1924 by 1556 pixels. Ultra-widefield fundus mosaic. 200° FOV
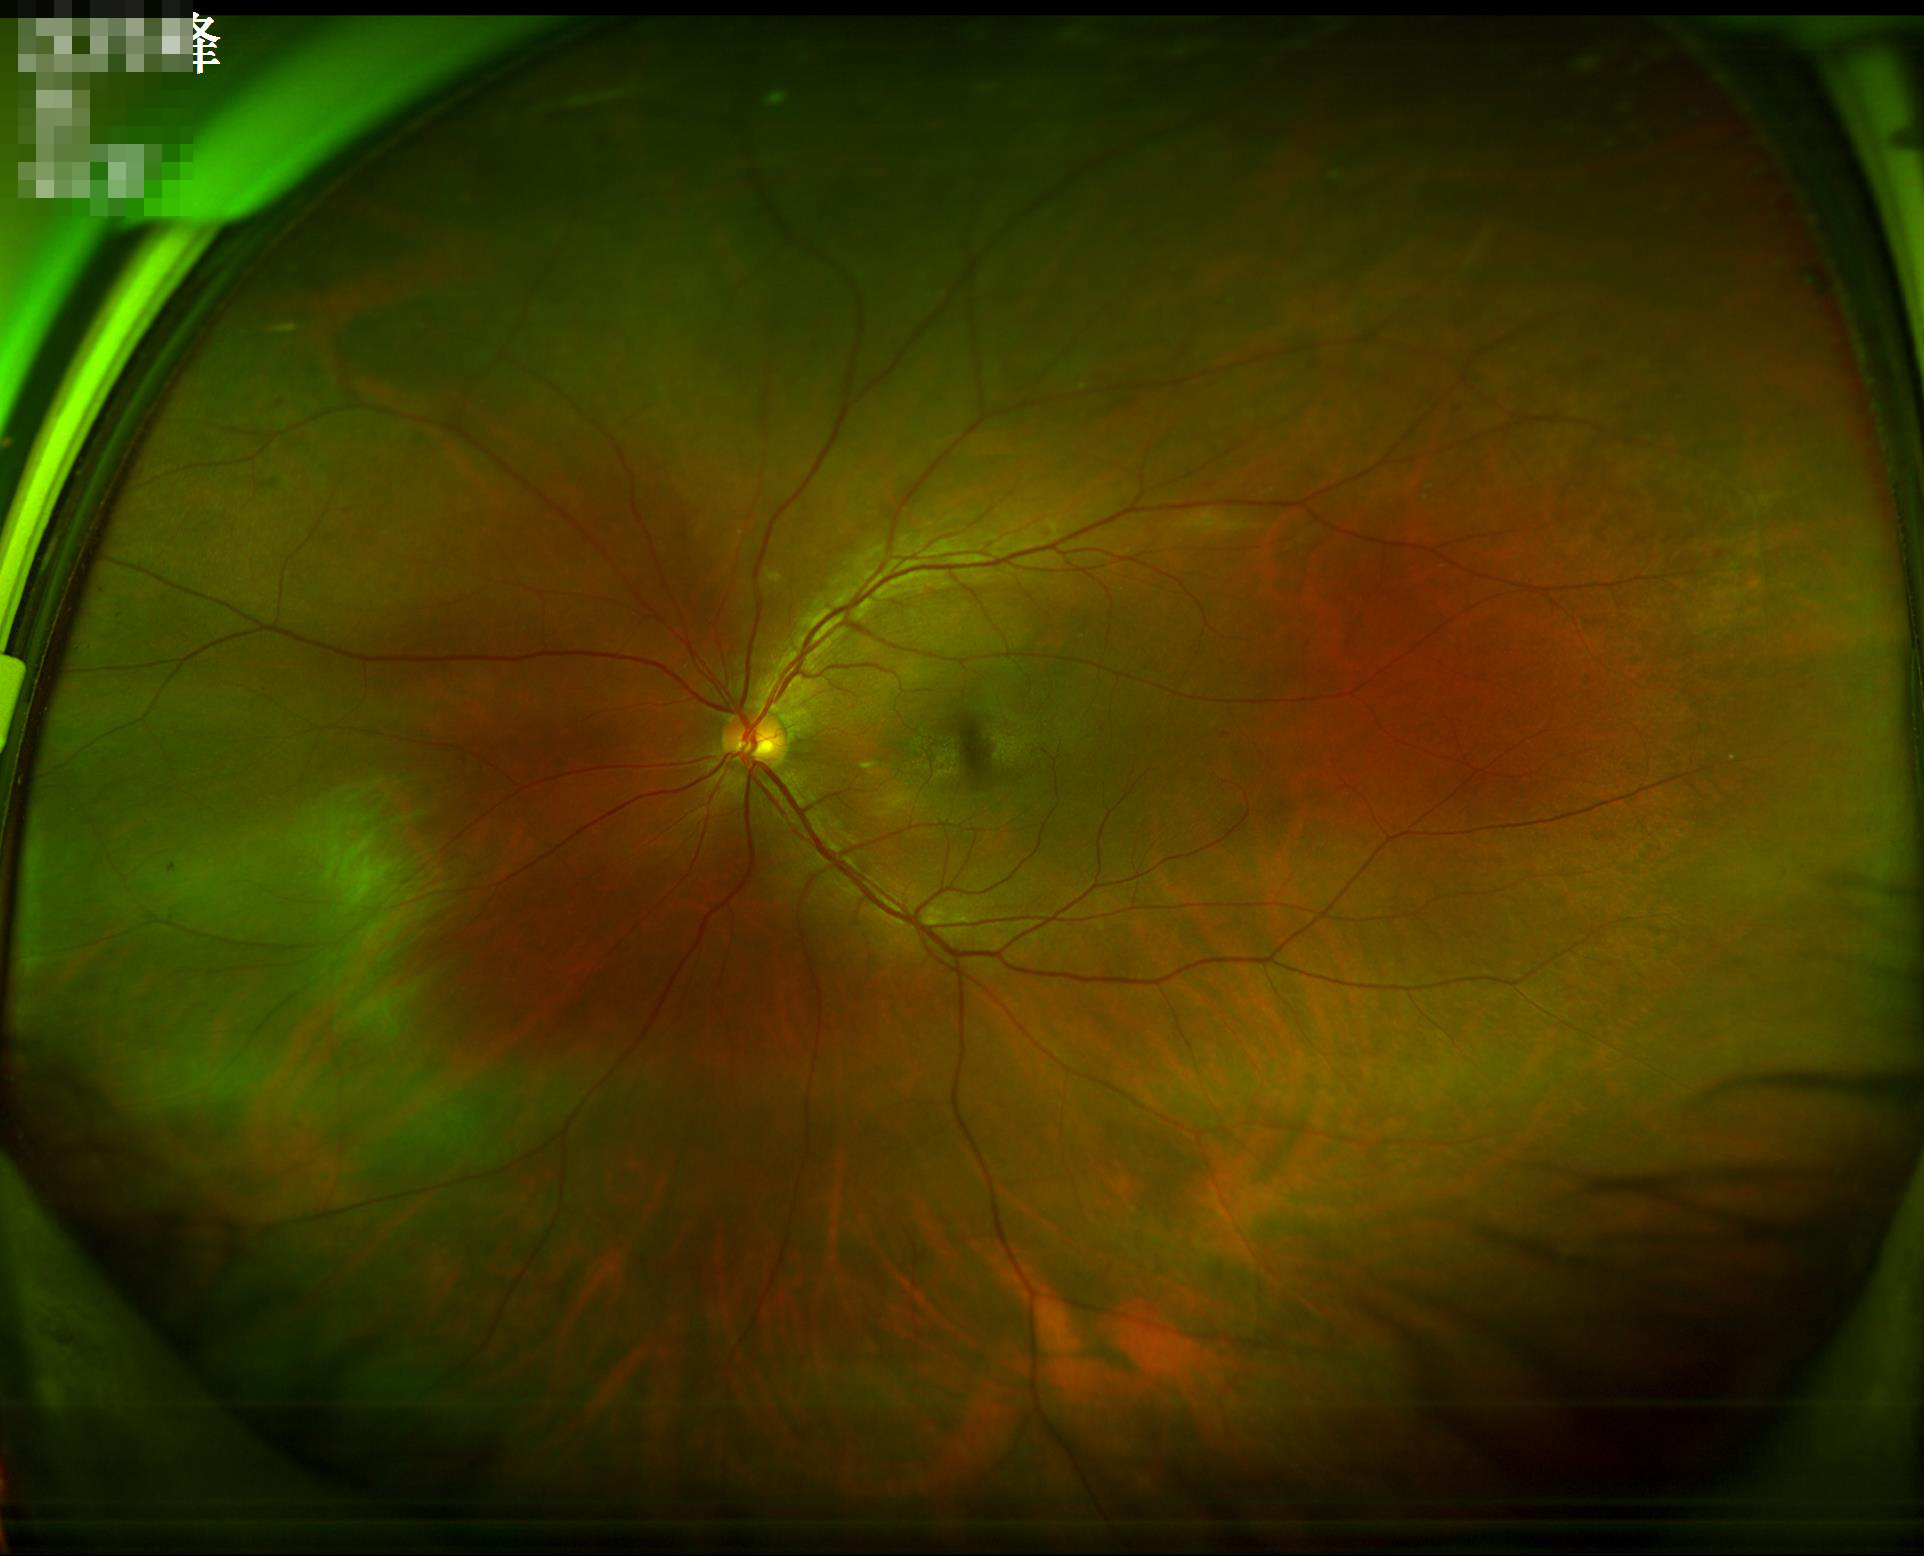

Image quality: overall: satisfactory | illumination: satisfactory.